Posterior pole color fundus photograph · 45 degree fundus photograph · nonmydriatic fundus photograph: 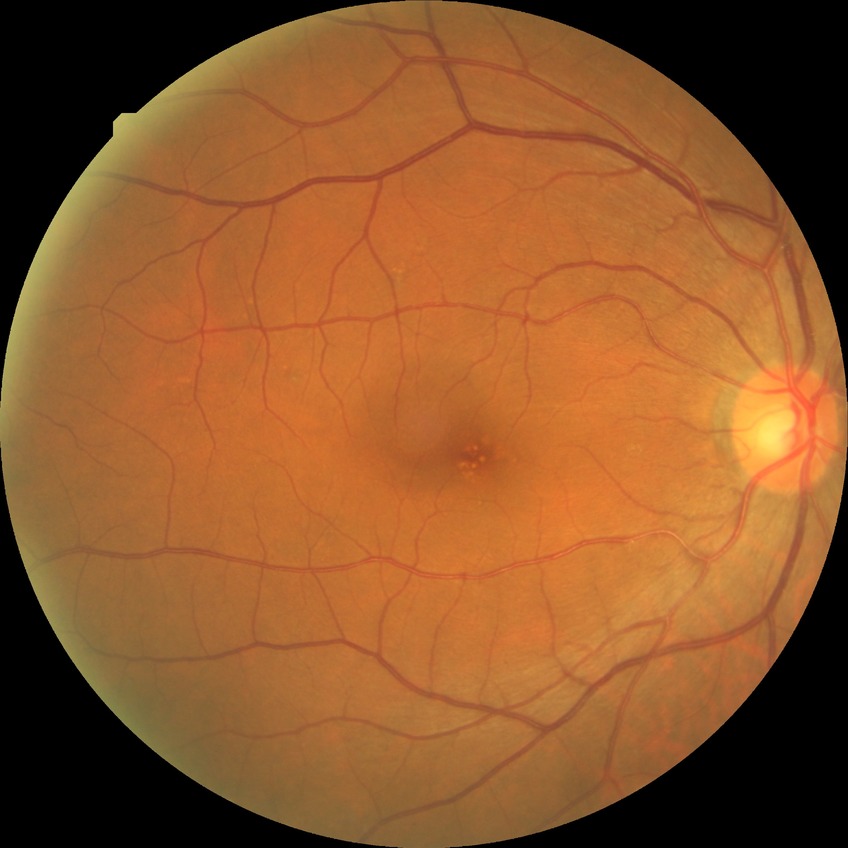 * diabetic retinopathy (DR) — NDR (no diabetic retinopathy)